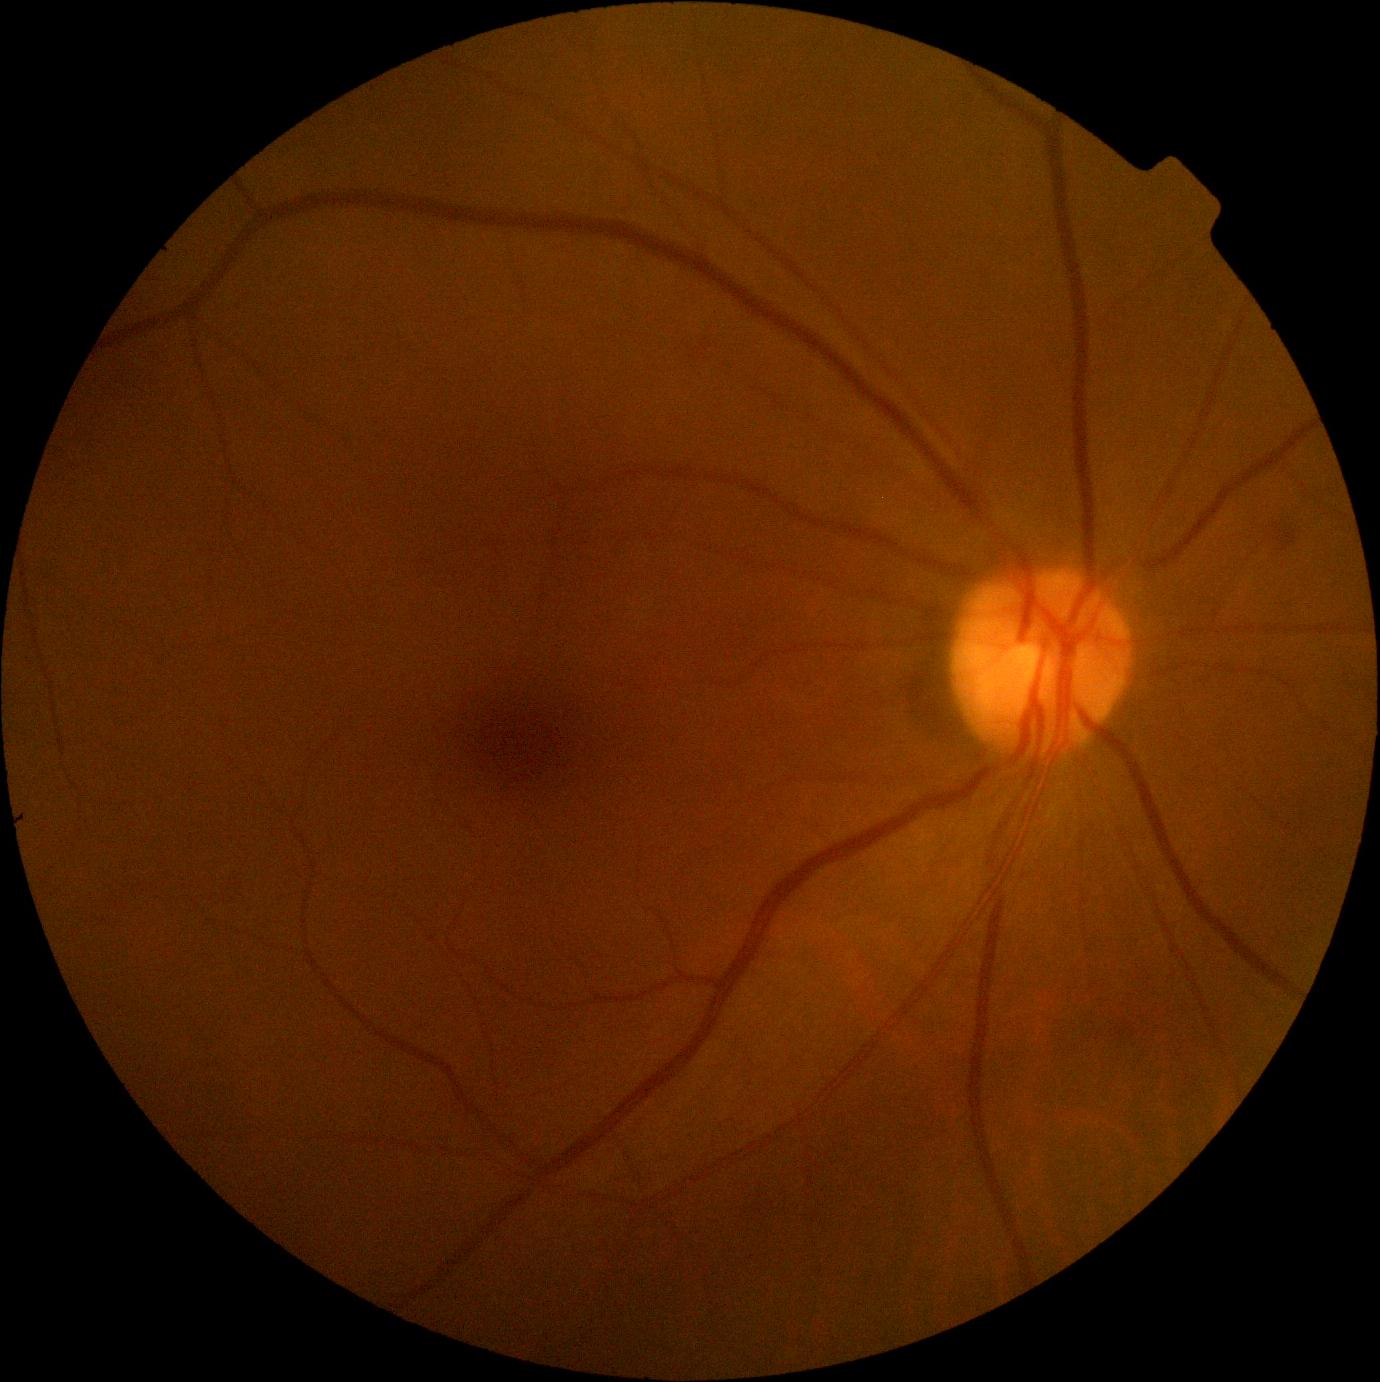 DR class: non-proliferative diabetic retinopathy. DR stage is moderate non-proliferative diabetic retinopathy (grade 2).